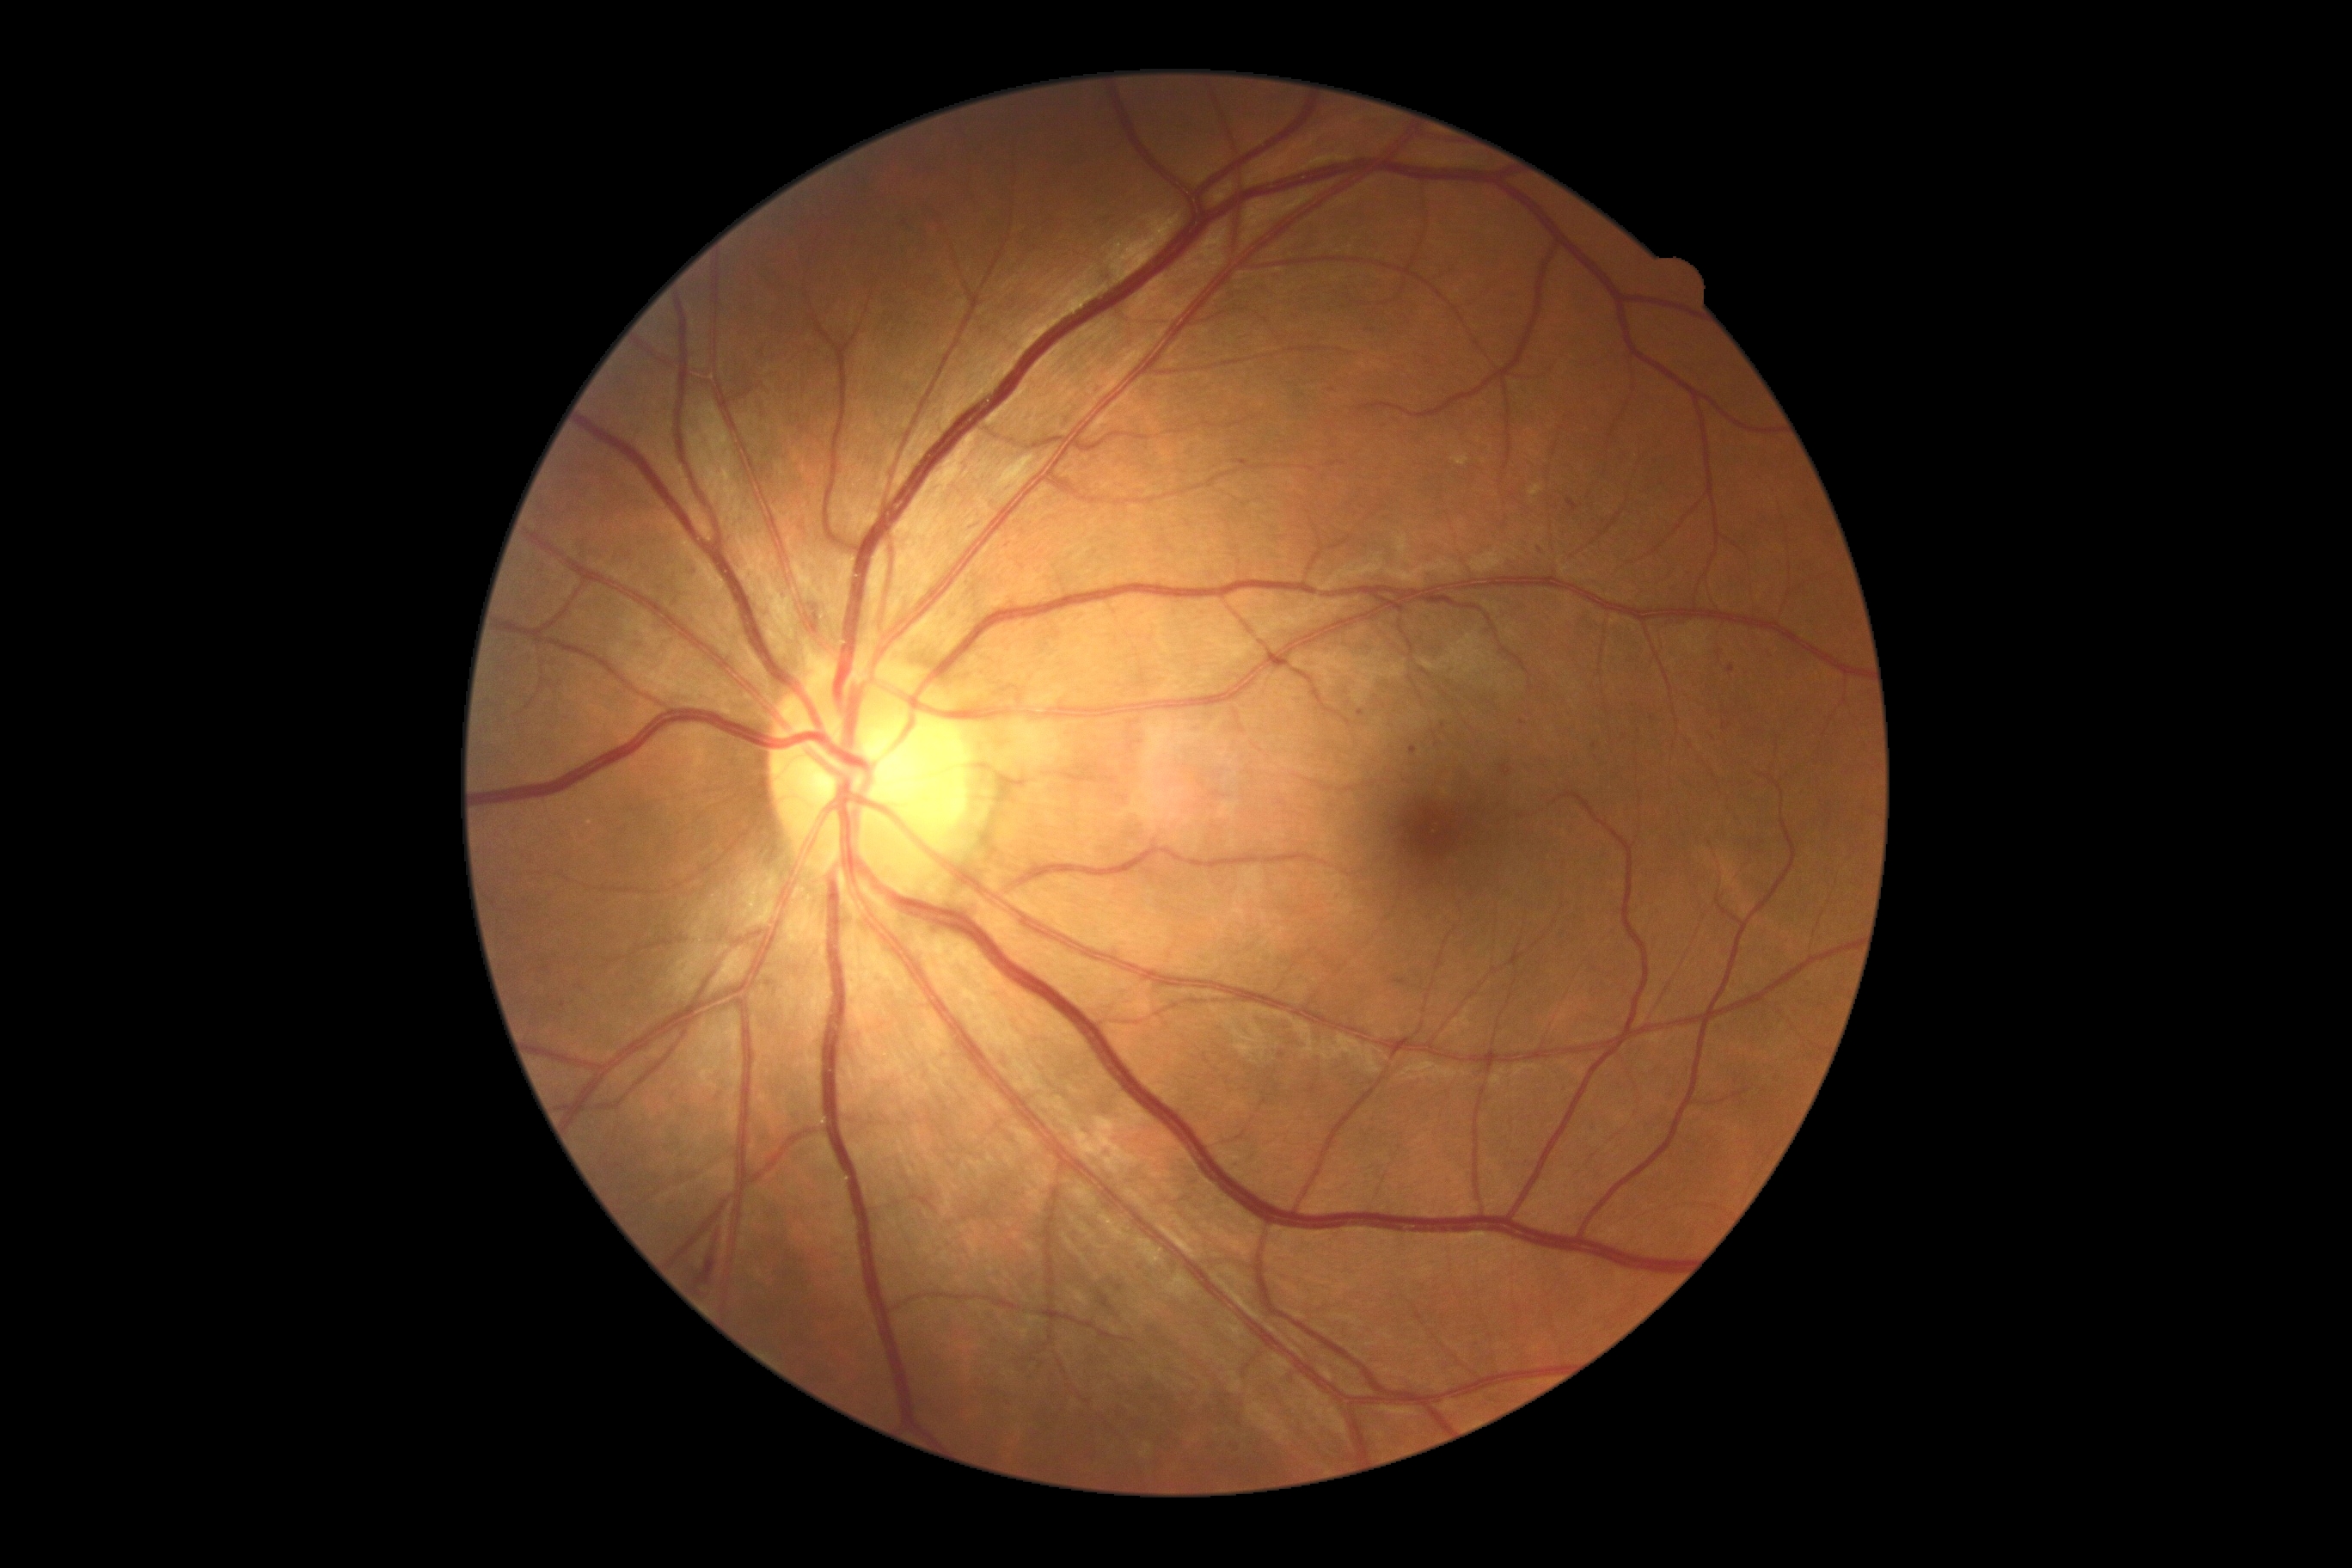

{"dr_grade": "2/4", "dr_category": "non-proliferative diabetic retinopathy"}